Posterior pole color fundus photograph
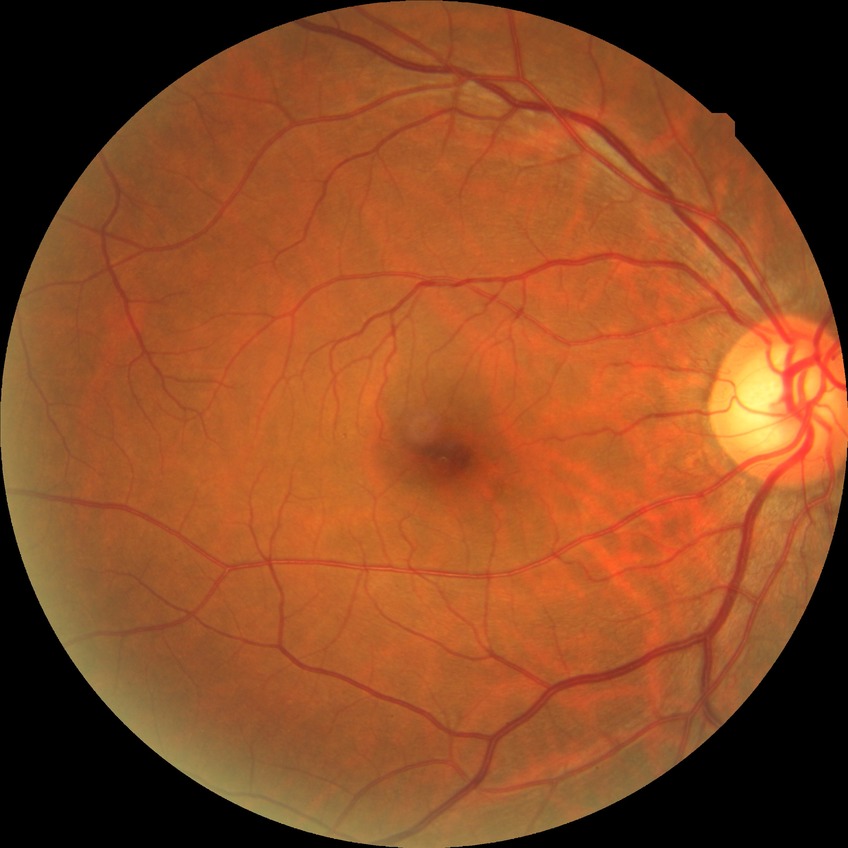 DR severity is NDR.